1932 x 1932 pixels
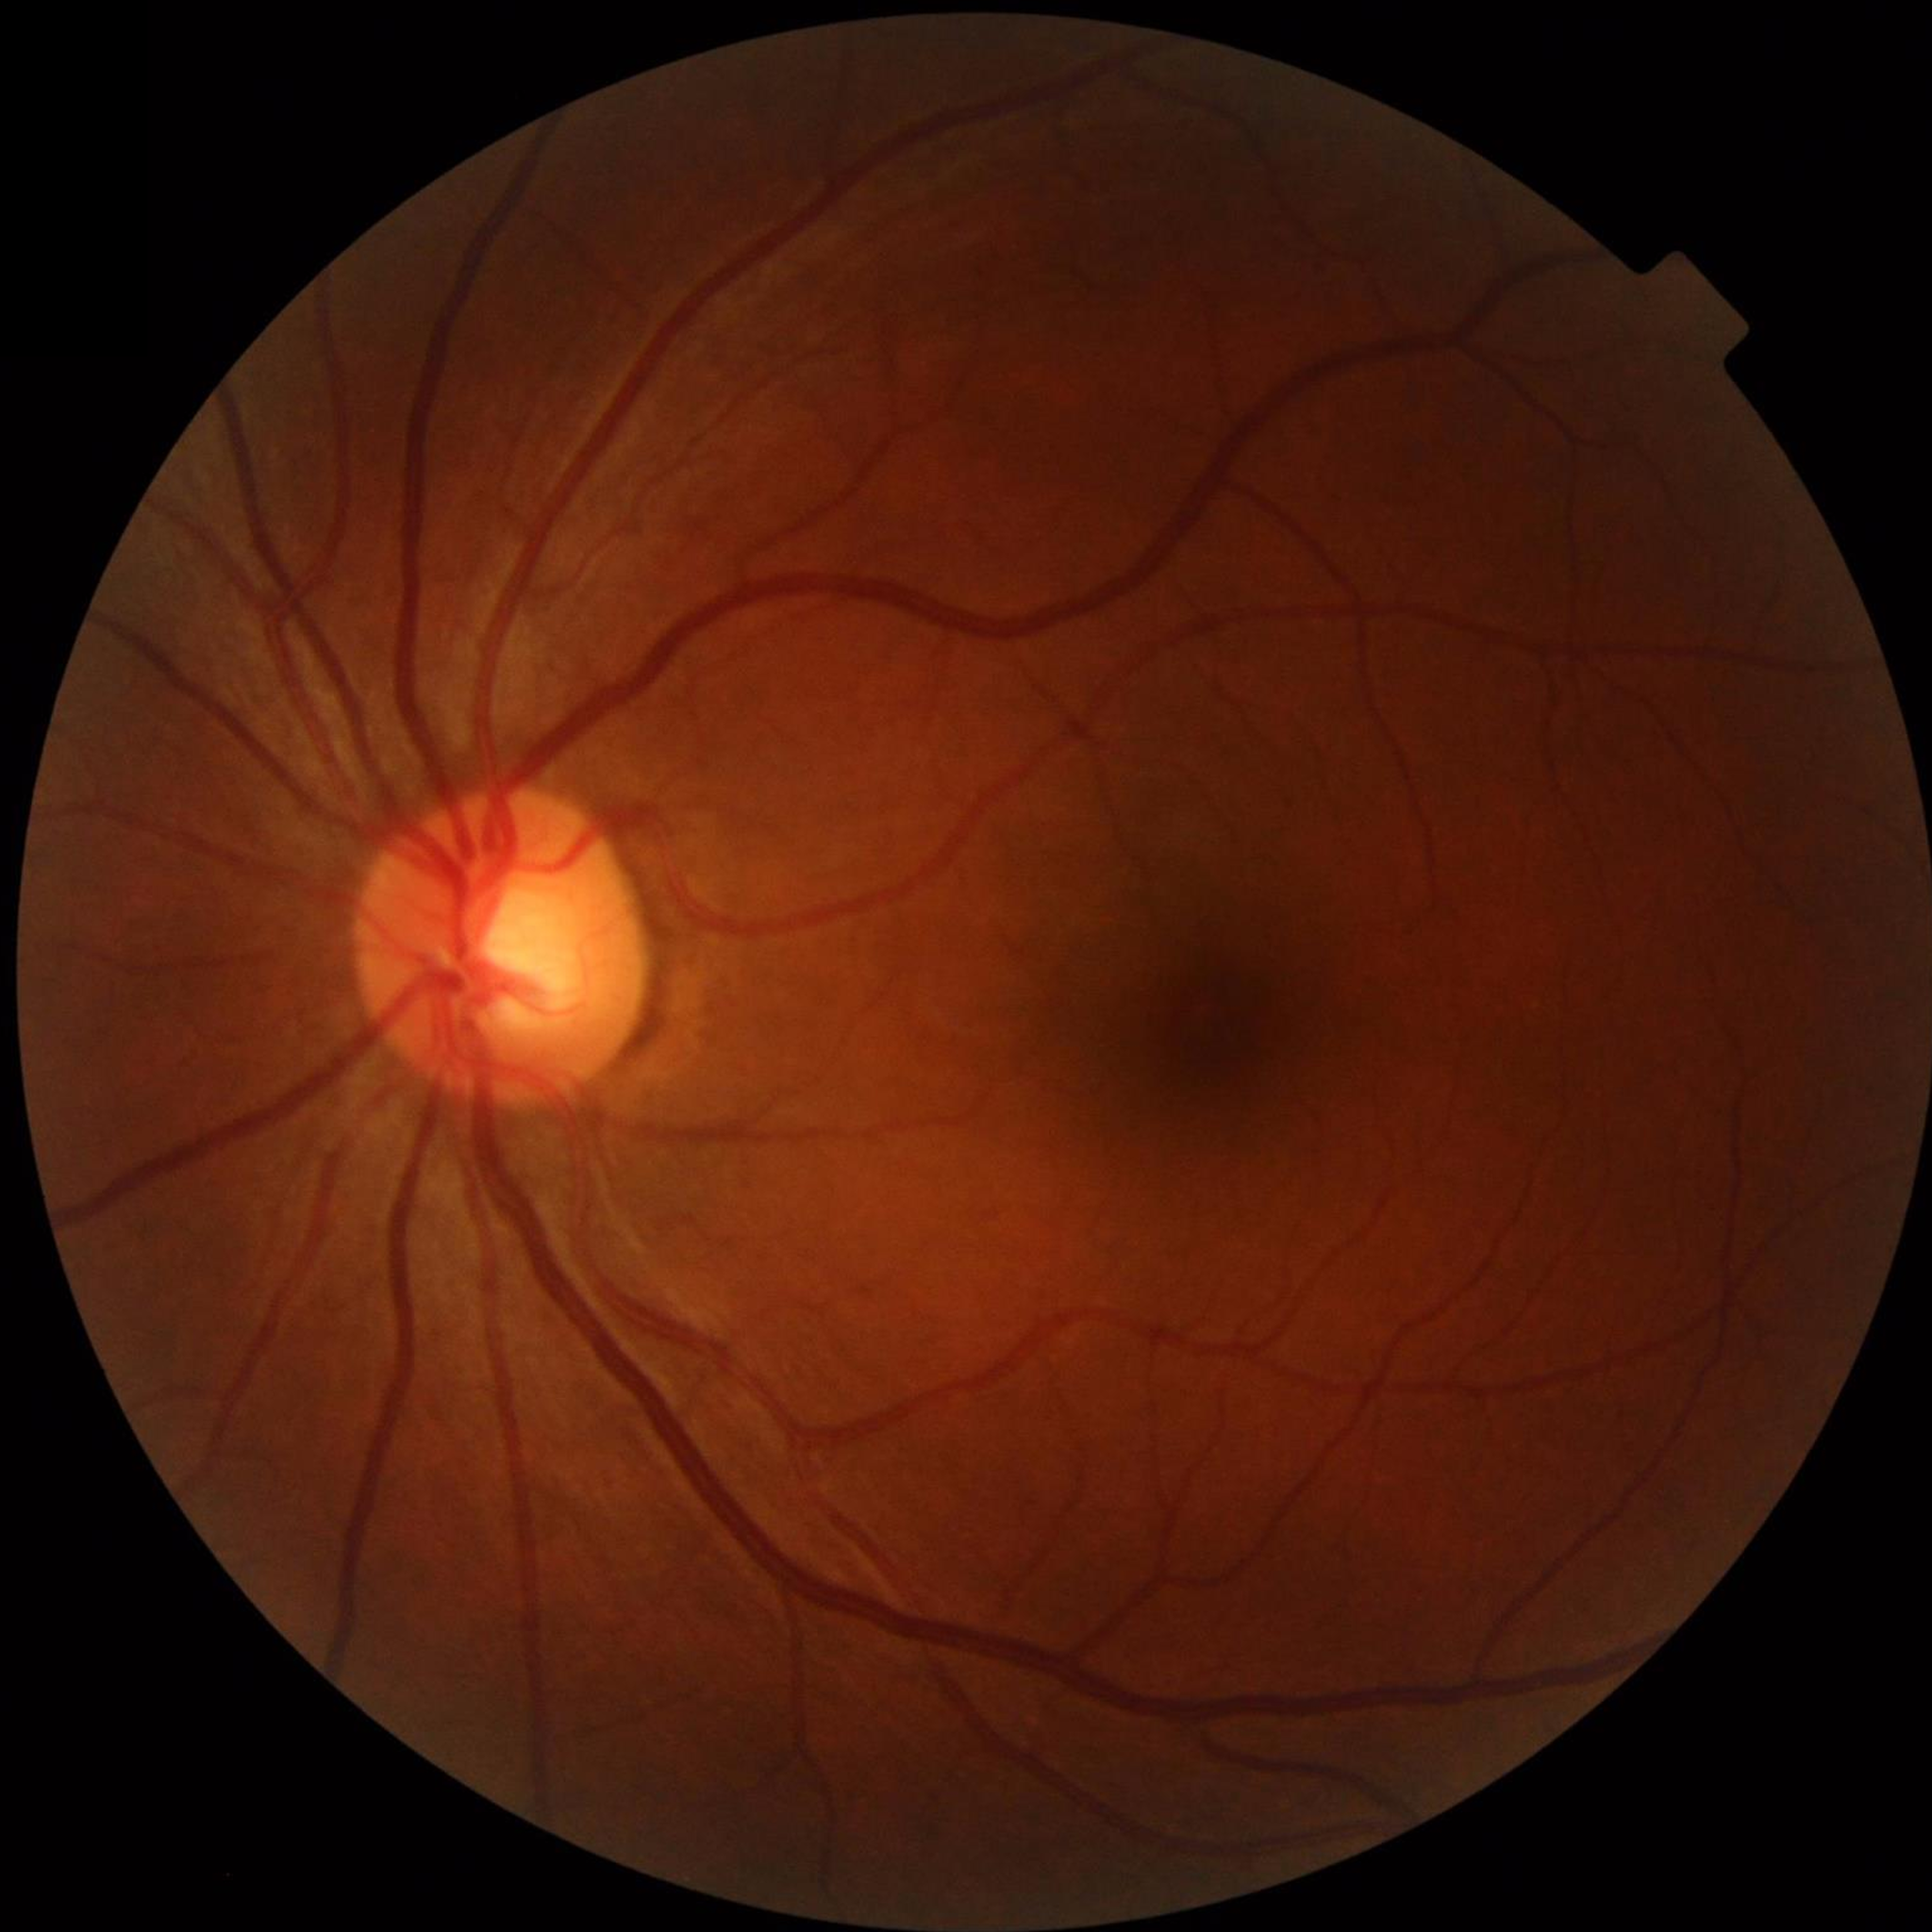

Color fundus photo from a control patient without diagnosed retinal disease.
Quality assessment: satisfactory.